Color fundus image
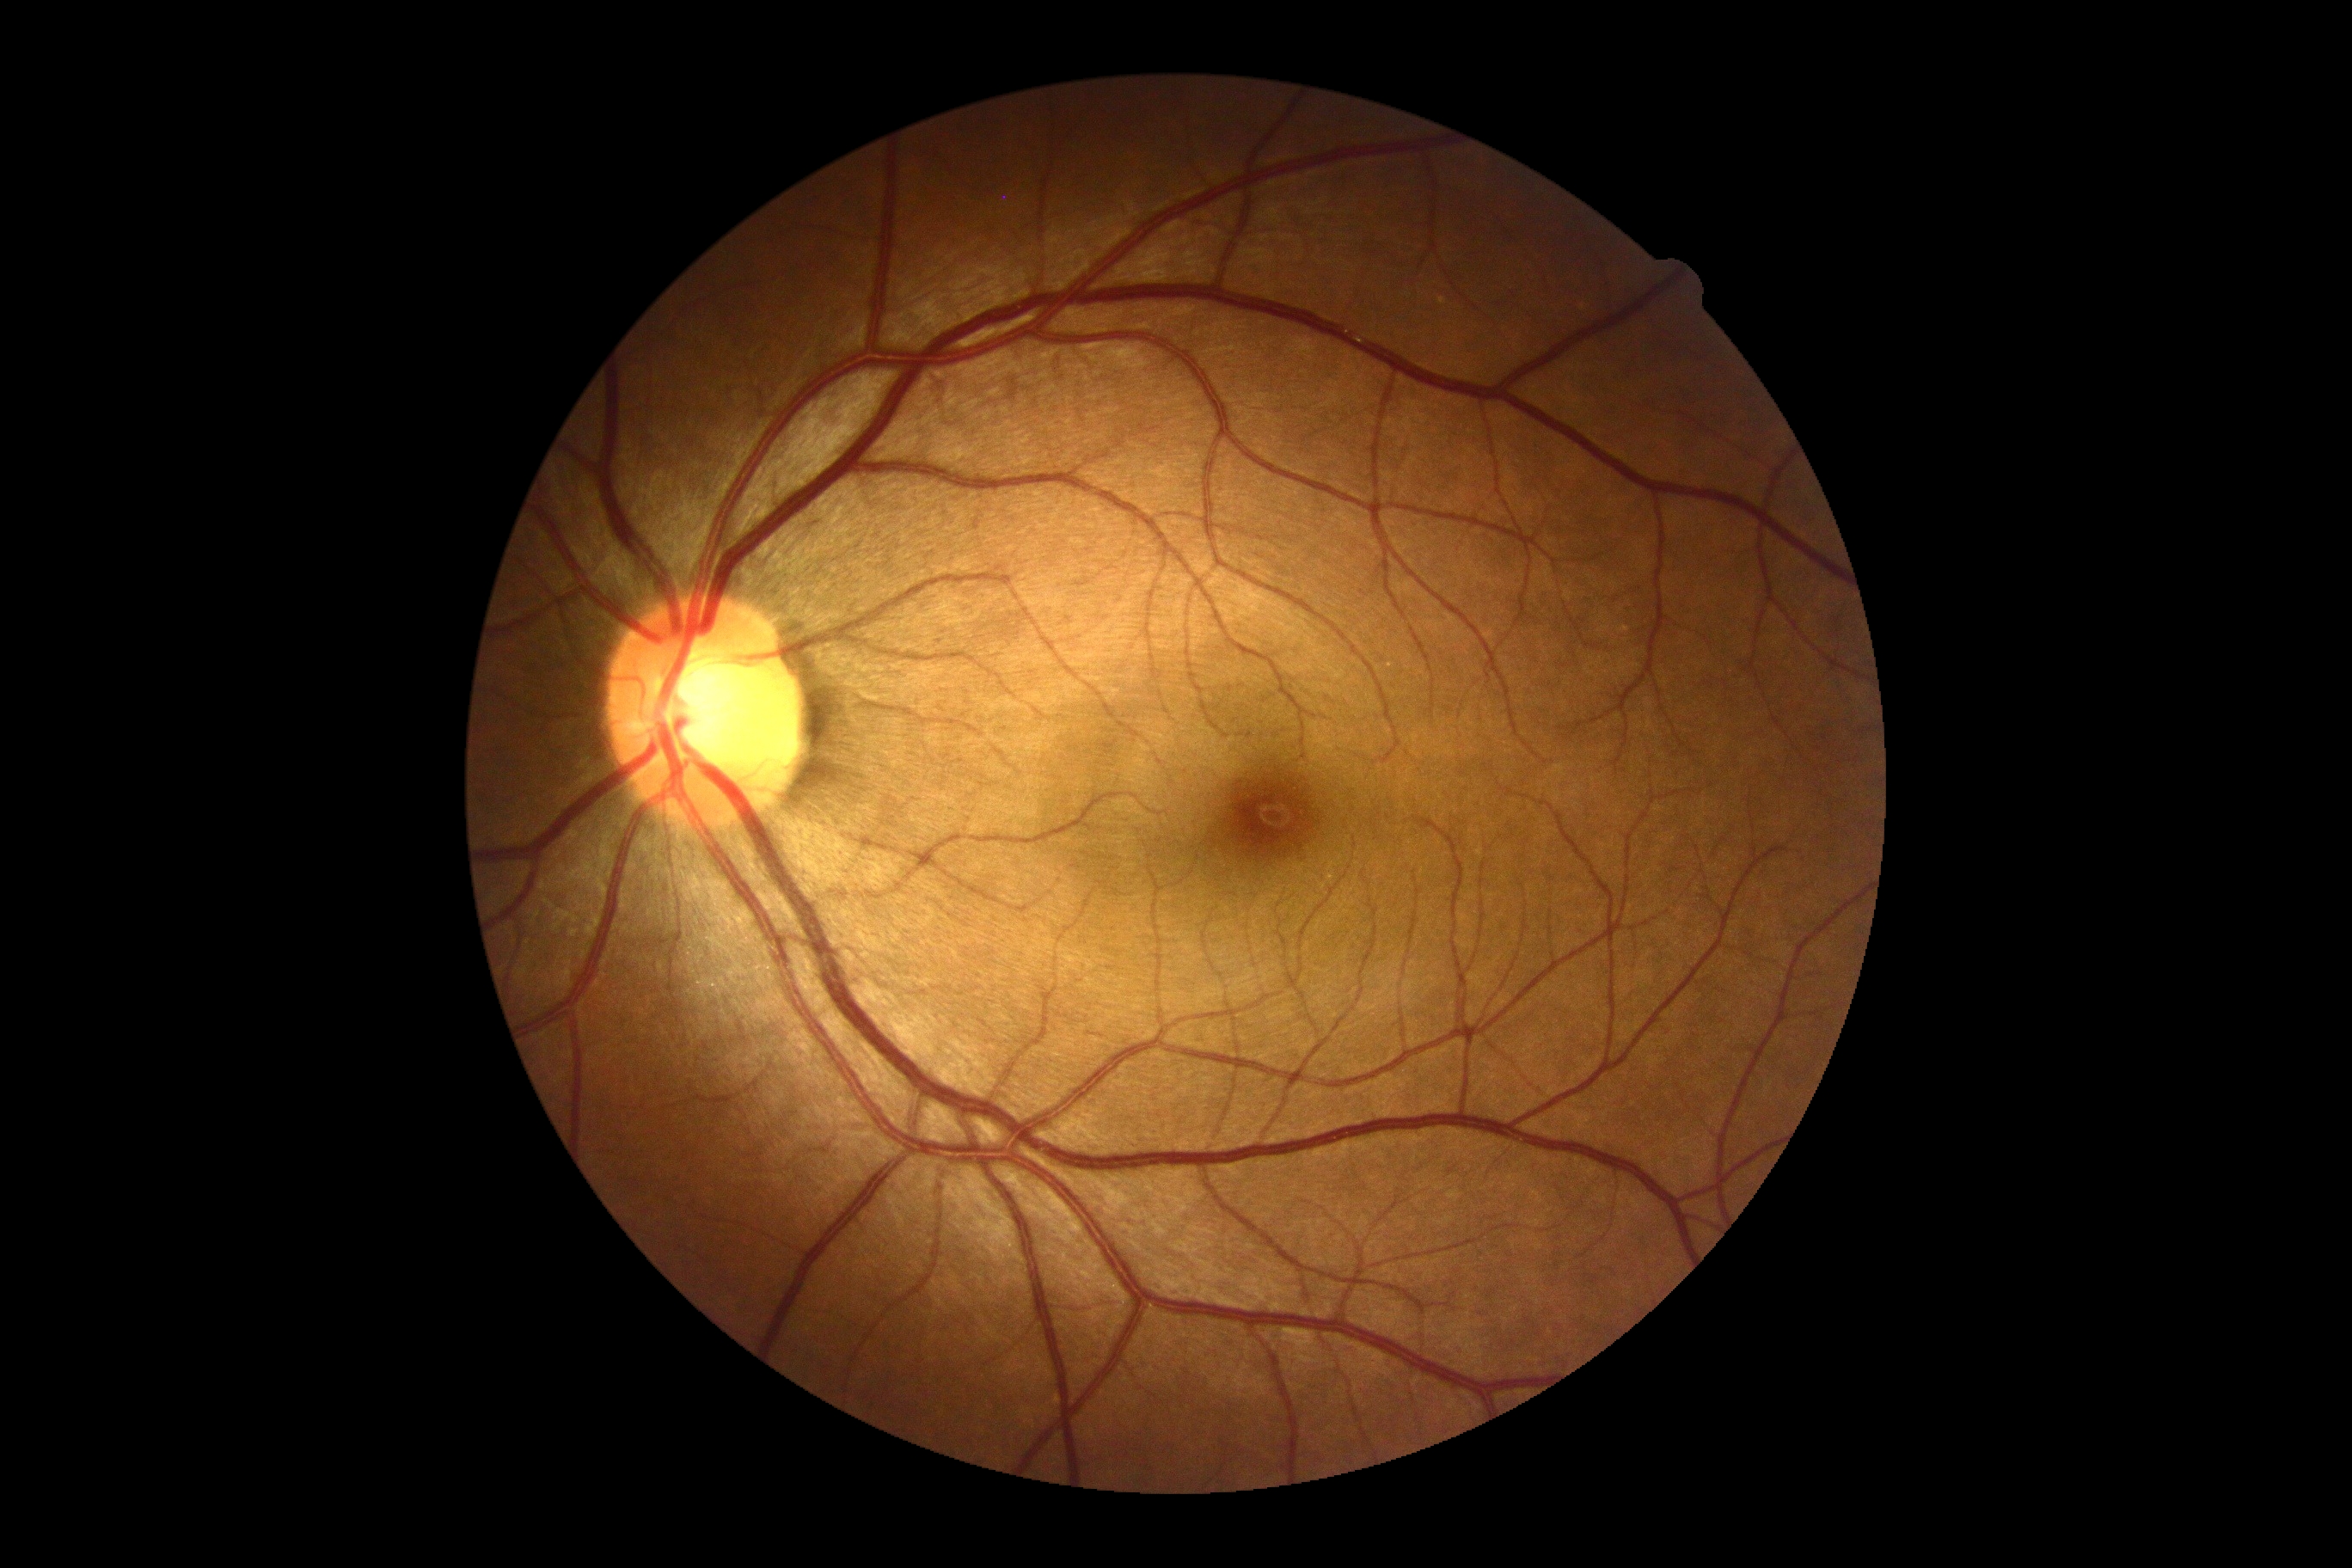

DR severity = no apparent diabetic retinopathy (grade 0).